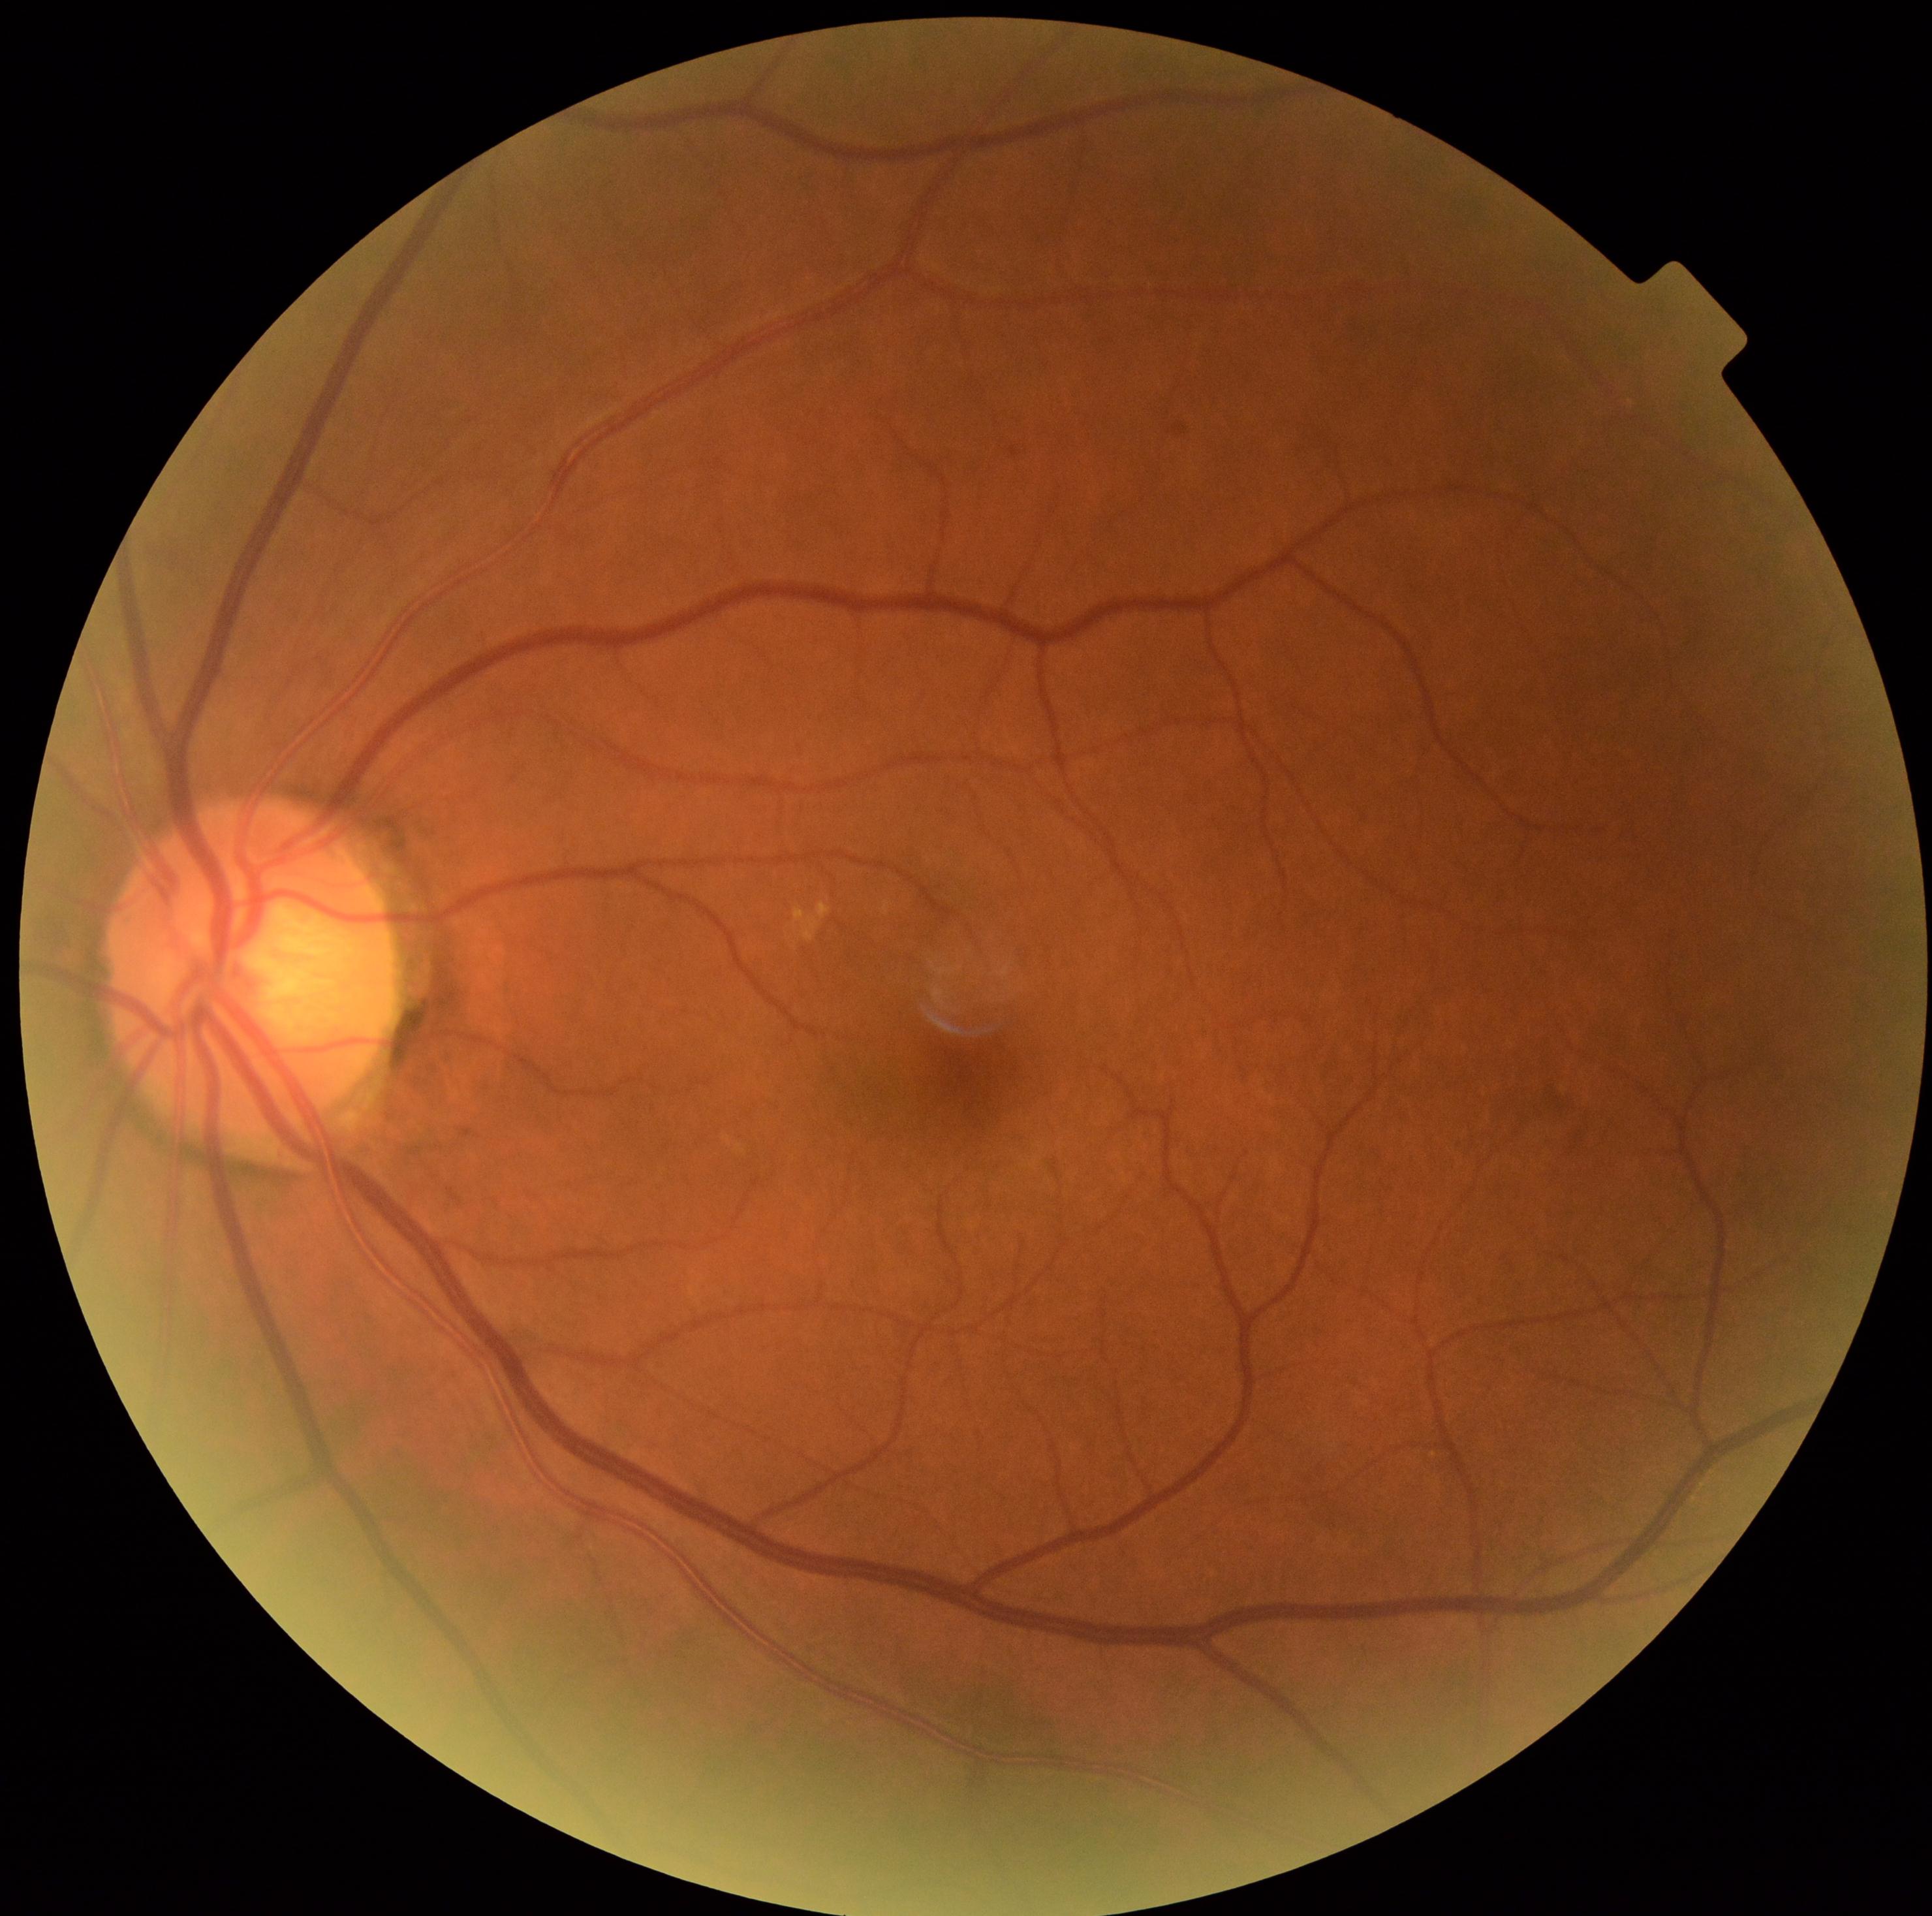 {"dr_grade": "grade 0 (no apparent retinopathy) — no visible signs of diabetic retinopathy"}